1240 x 1240 pixels · acquired on the Phoenix ICON · wide-field contact fundus photograph of an infant — 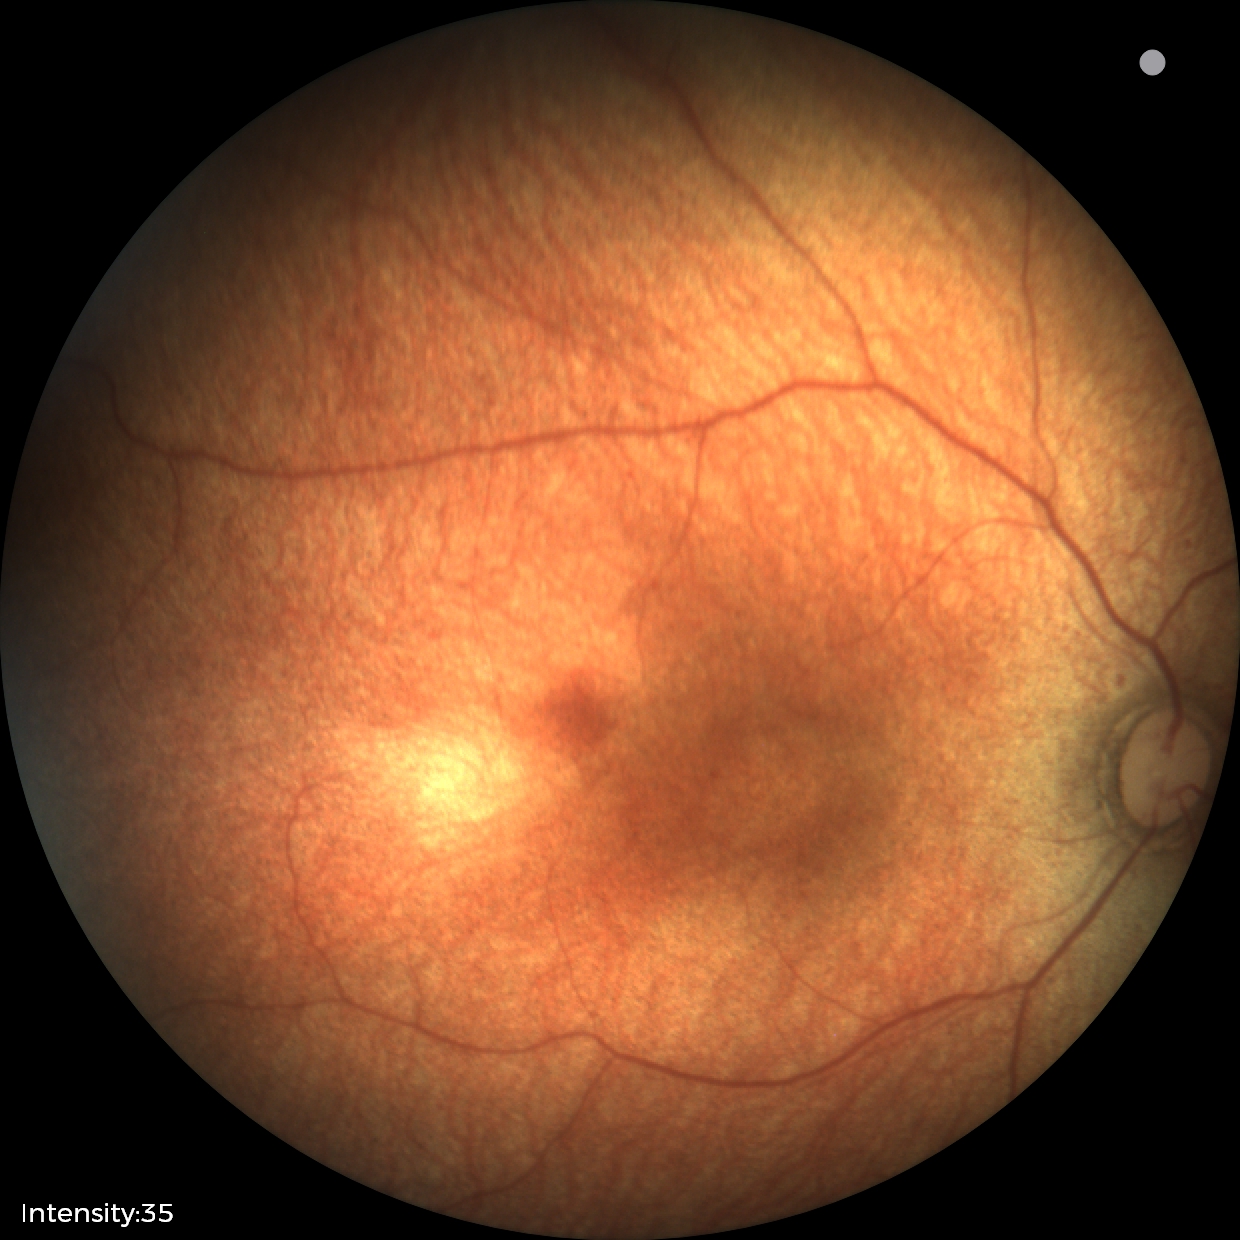

Q: What is the diagnosis from this examination?
A: normal fundus examination